Macula-centered field; 50° field of view.
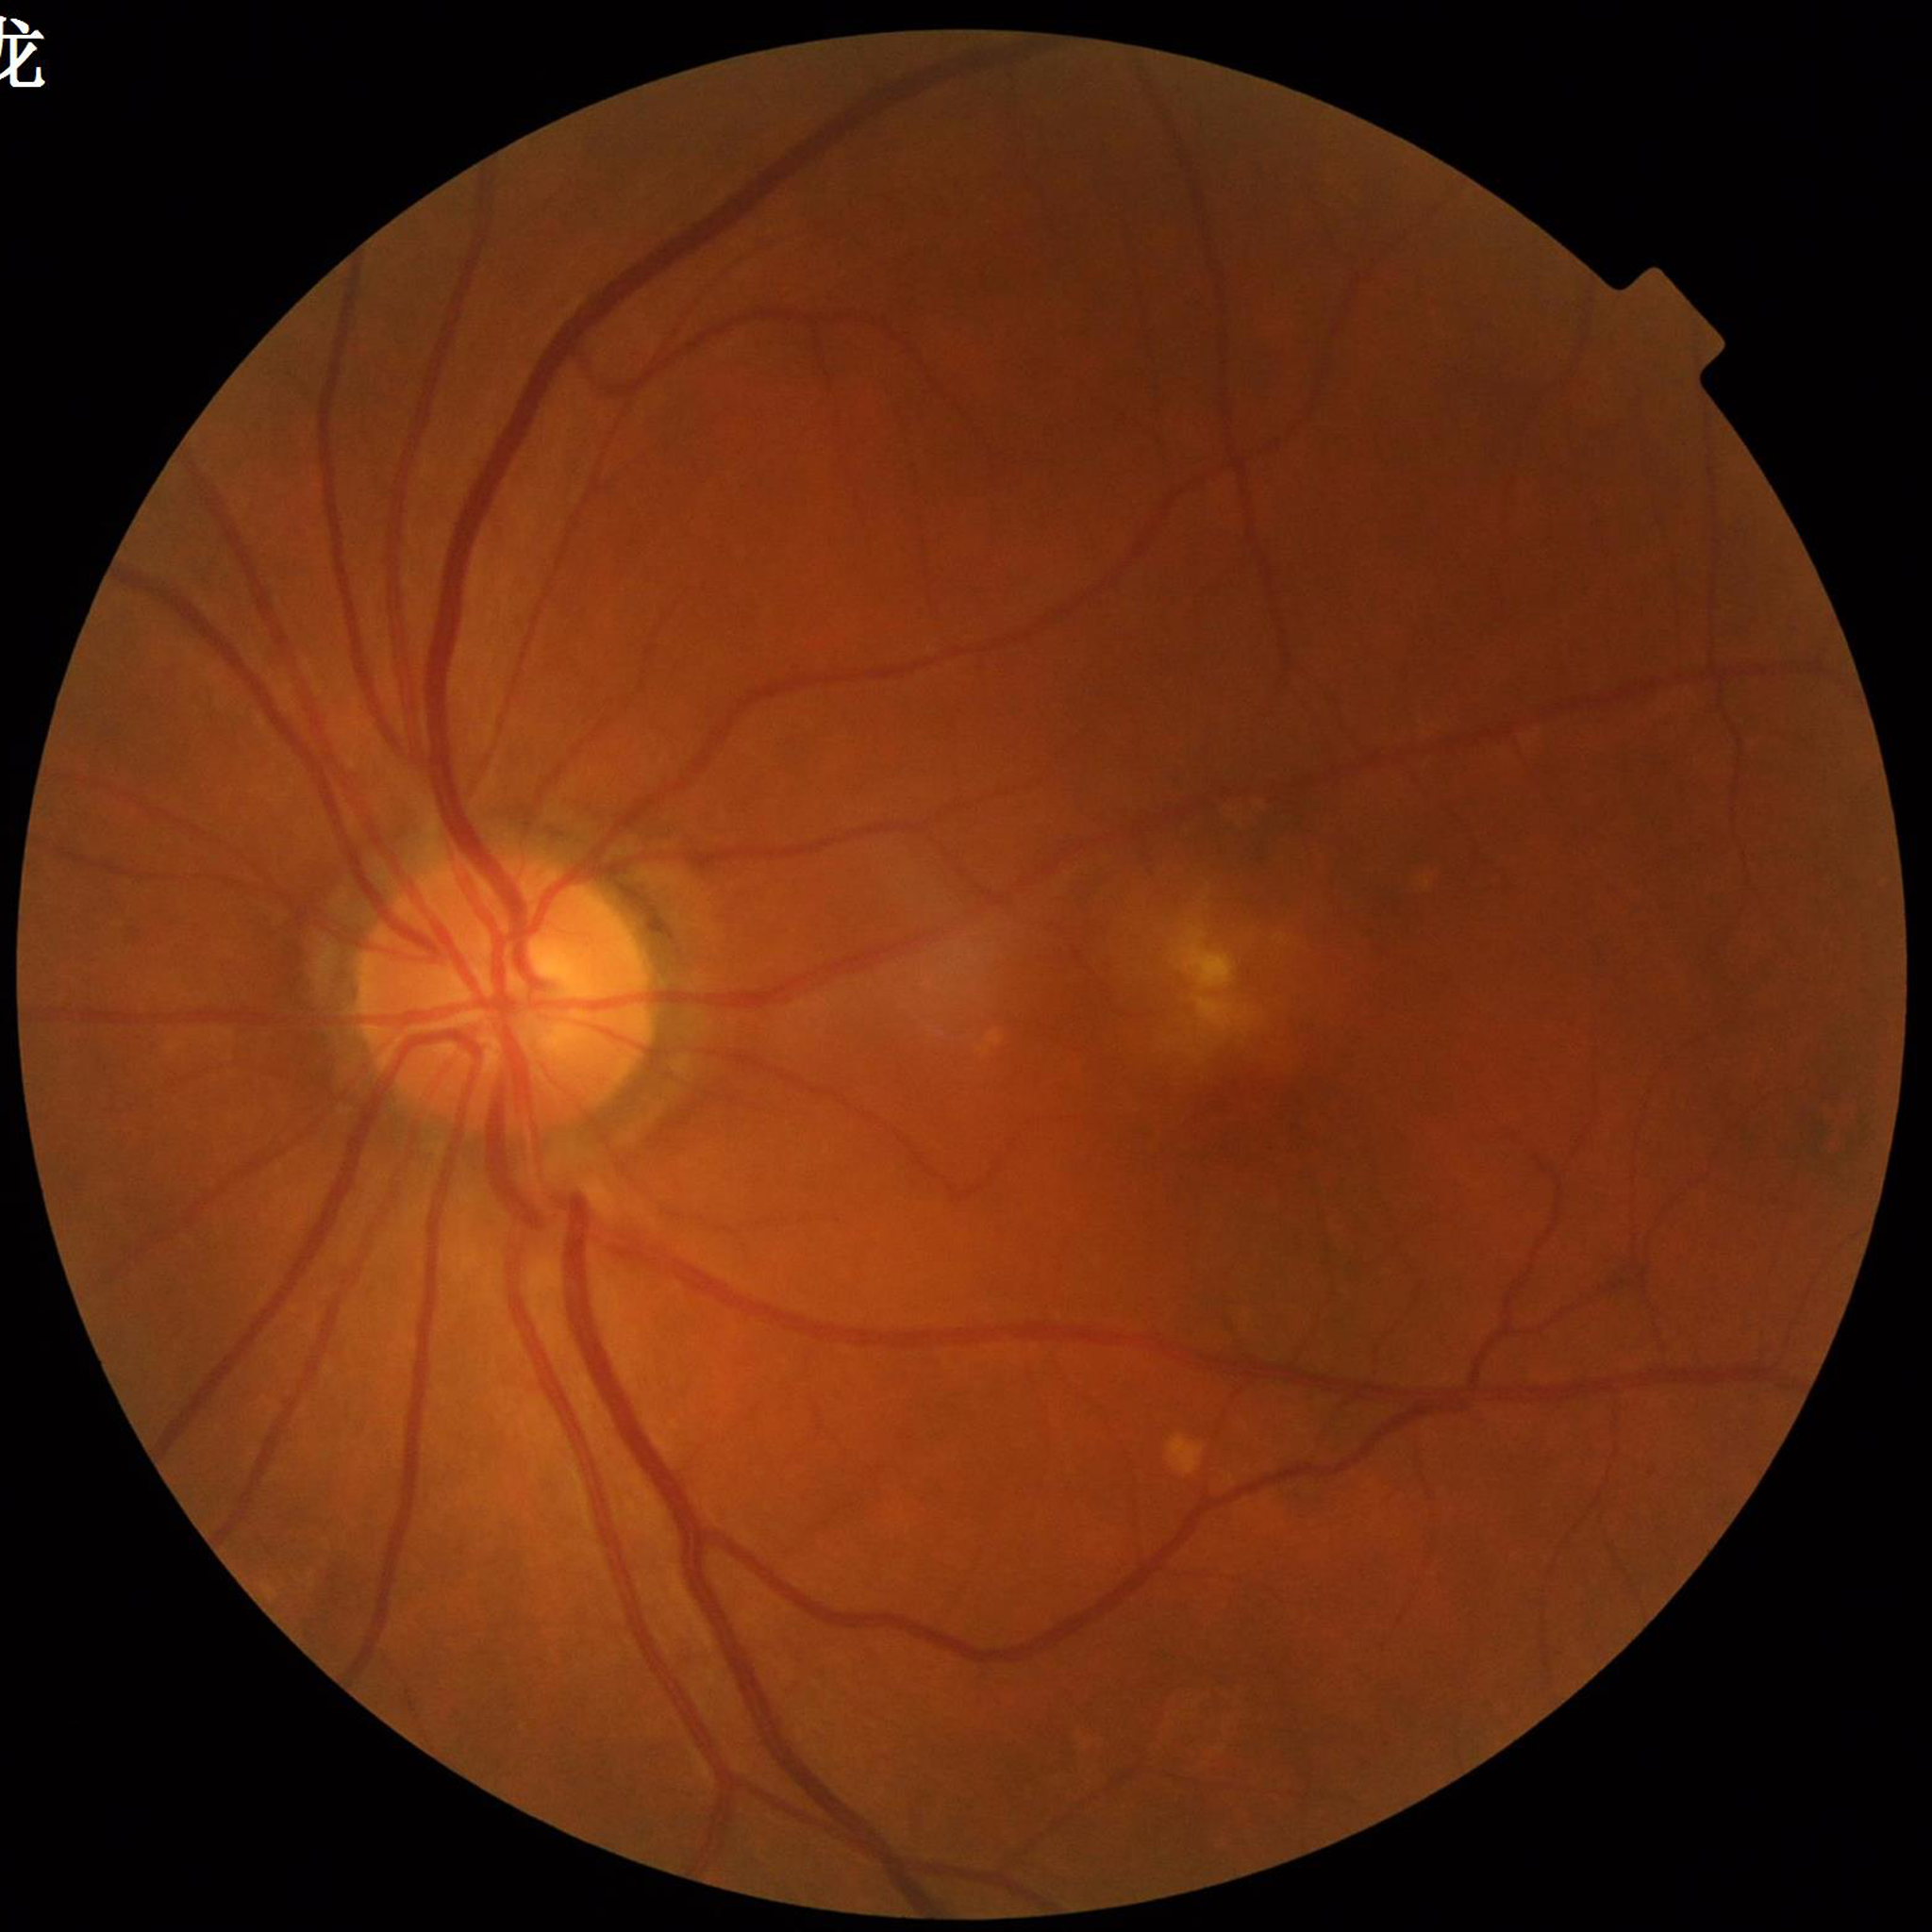

Impression: age-related macular degeneration